Graded on the modified Davis scale — 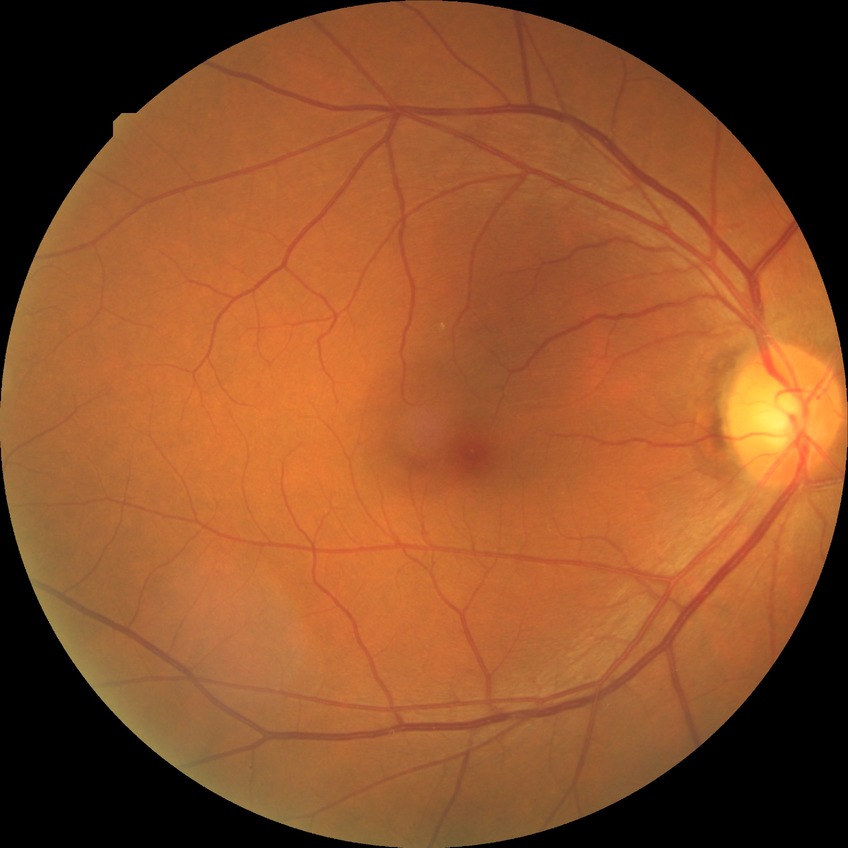 Diabetic retinopathy (DR): no diabetic retinopathy (NDR).